45-degree field of view:
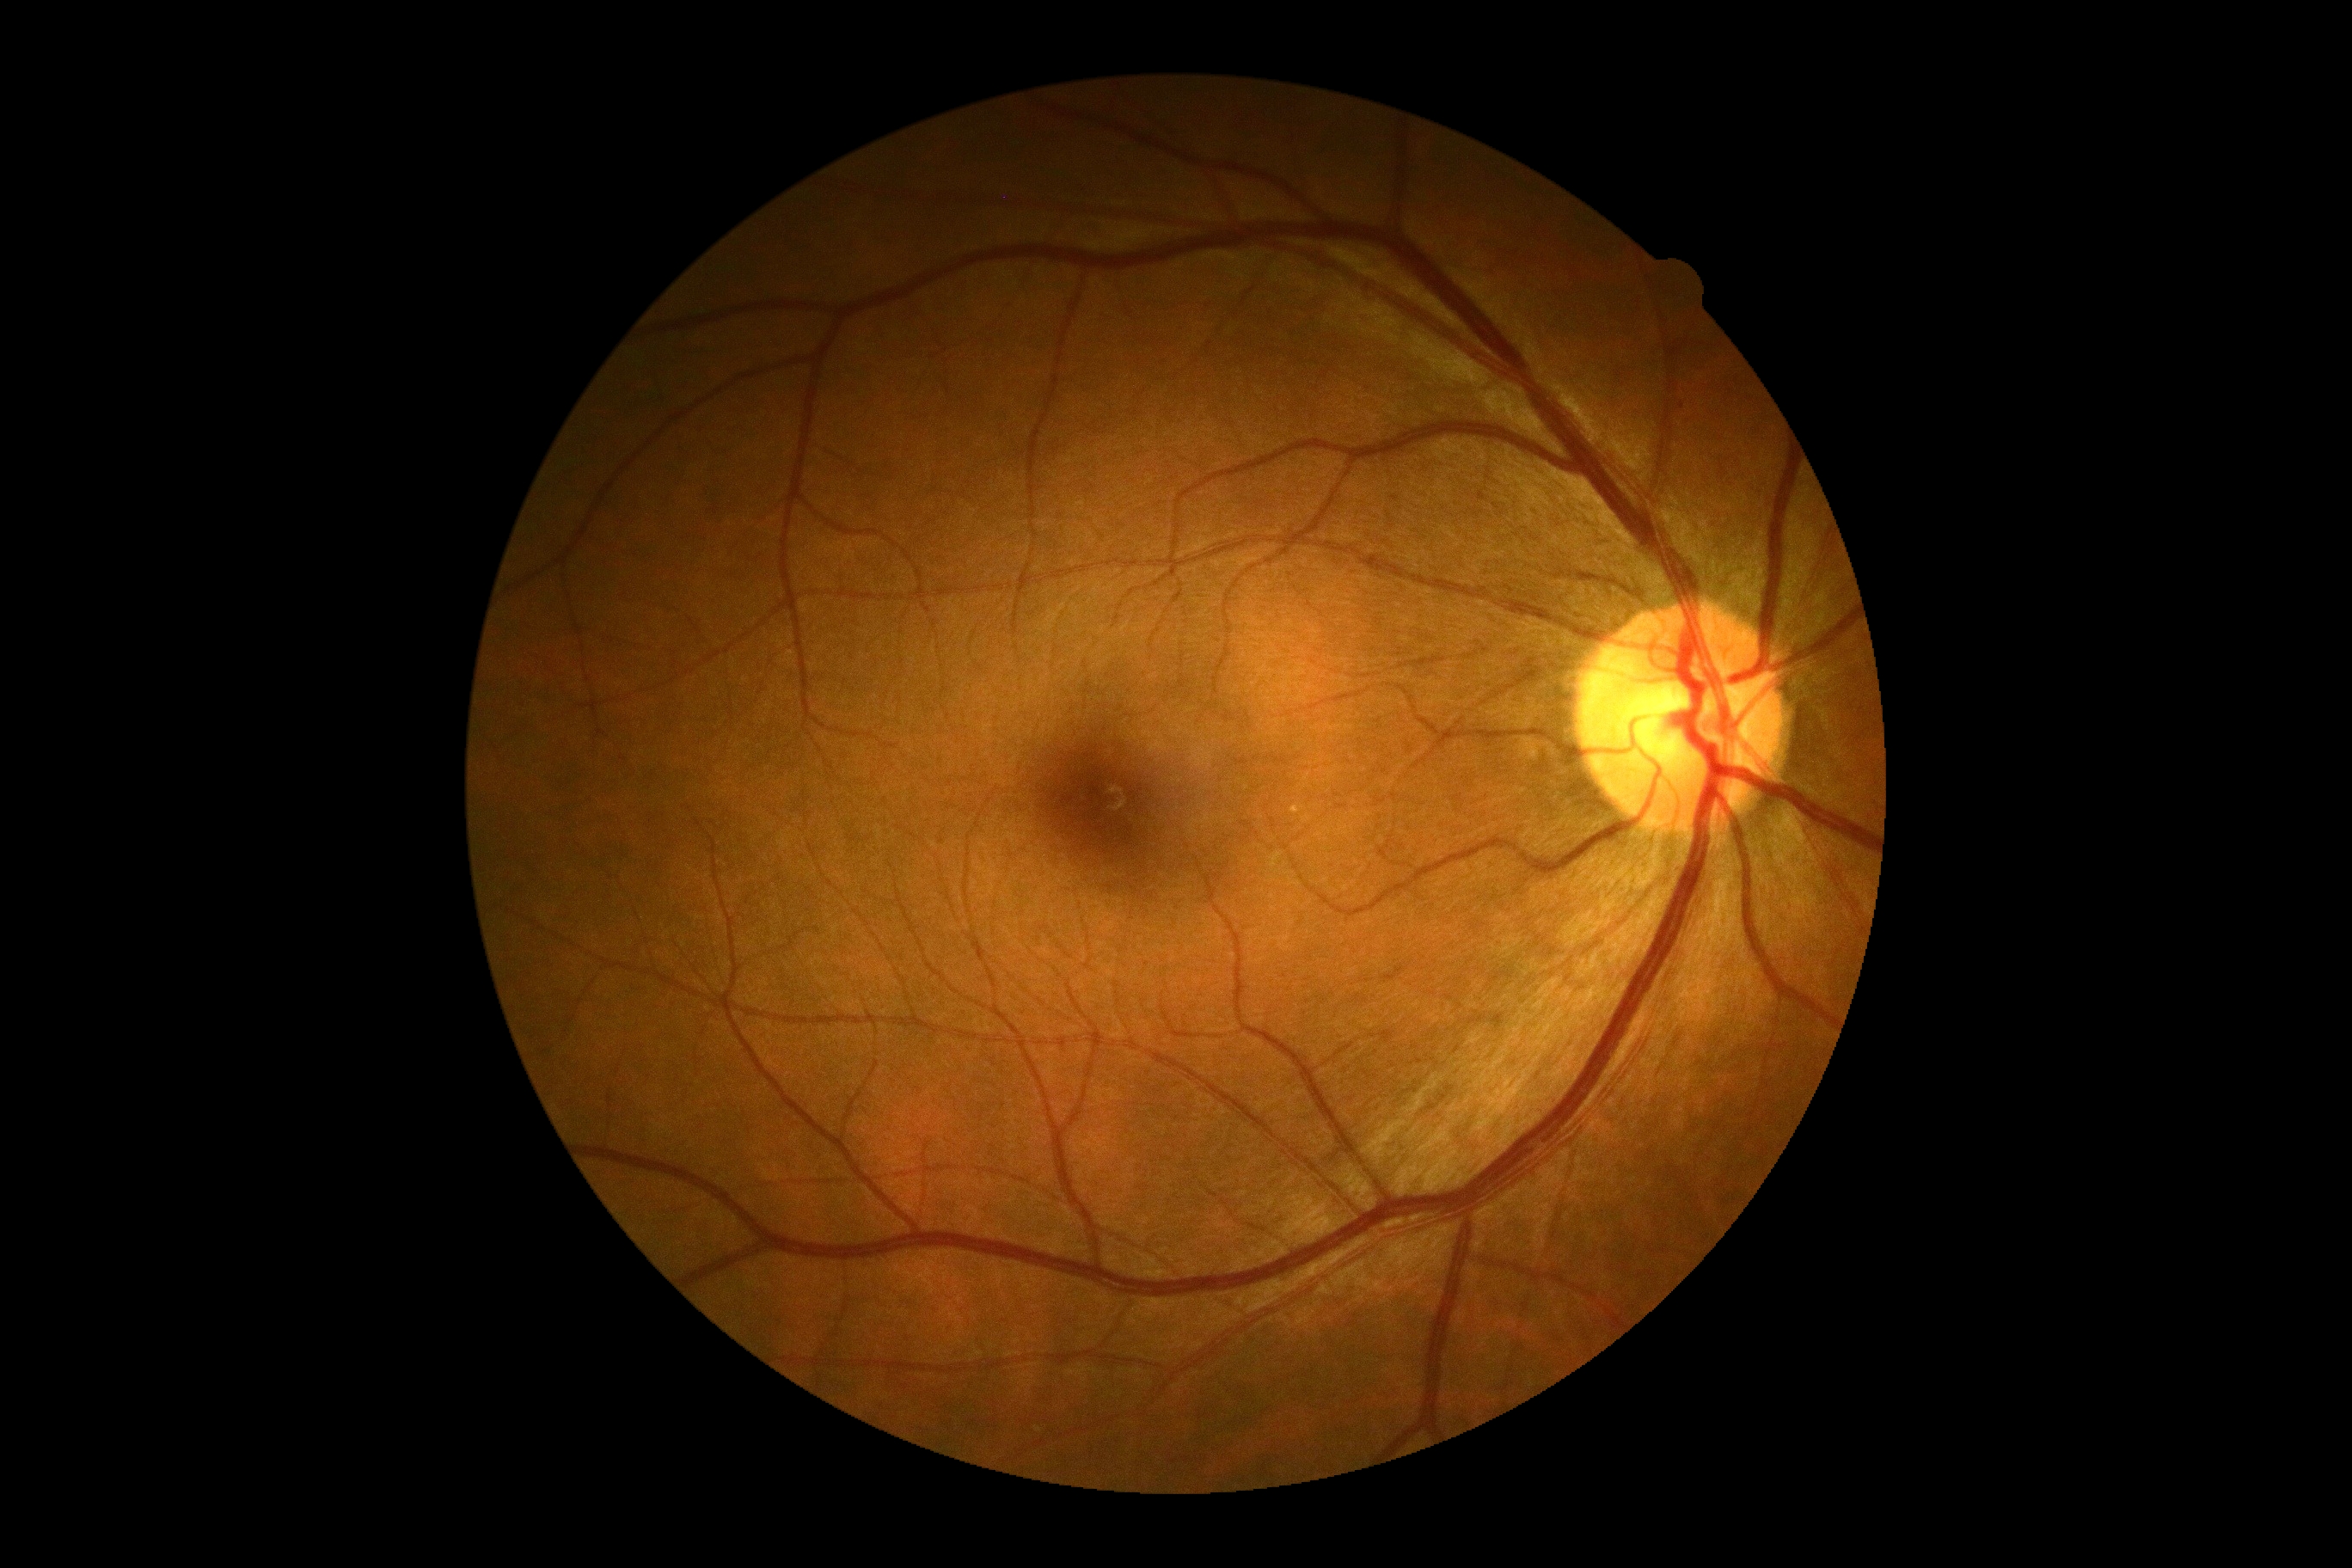 diabetic retinopathy = no apparent diabetic retinopathy (grade 0)